Modified Davis grading, acquired with a NIDEK AFC-230, 45 degree fundus photograph:
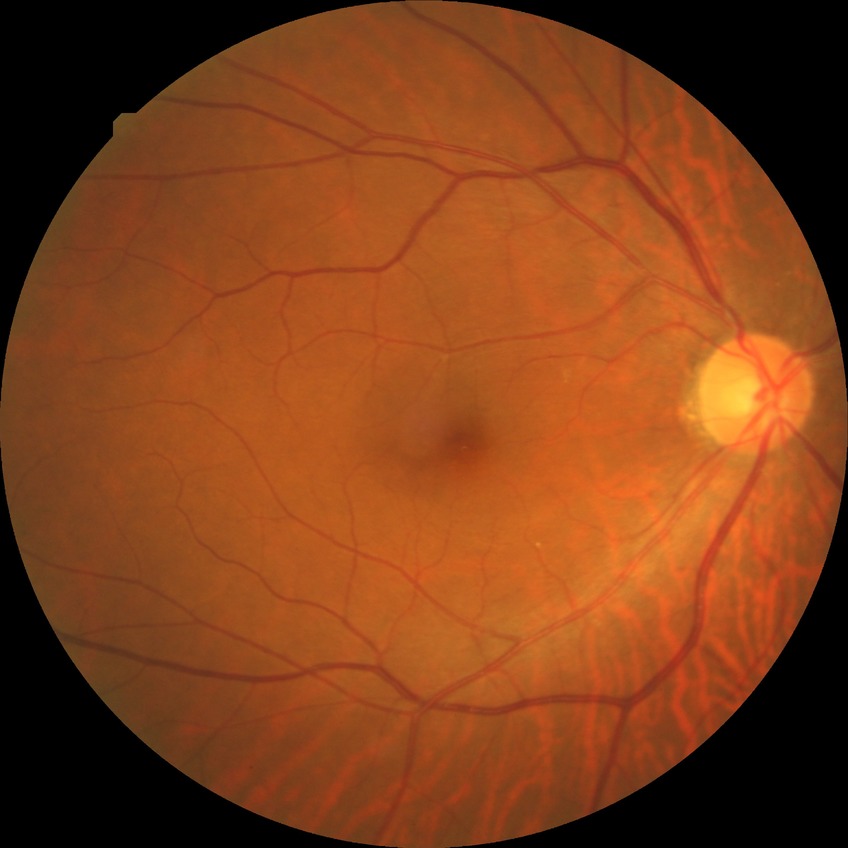

dr_impression: no signs of DR
davis_grade: NDR